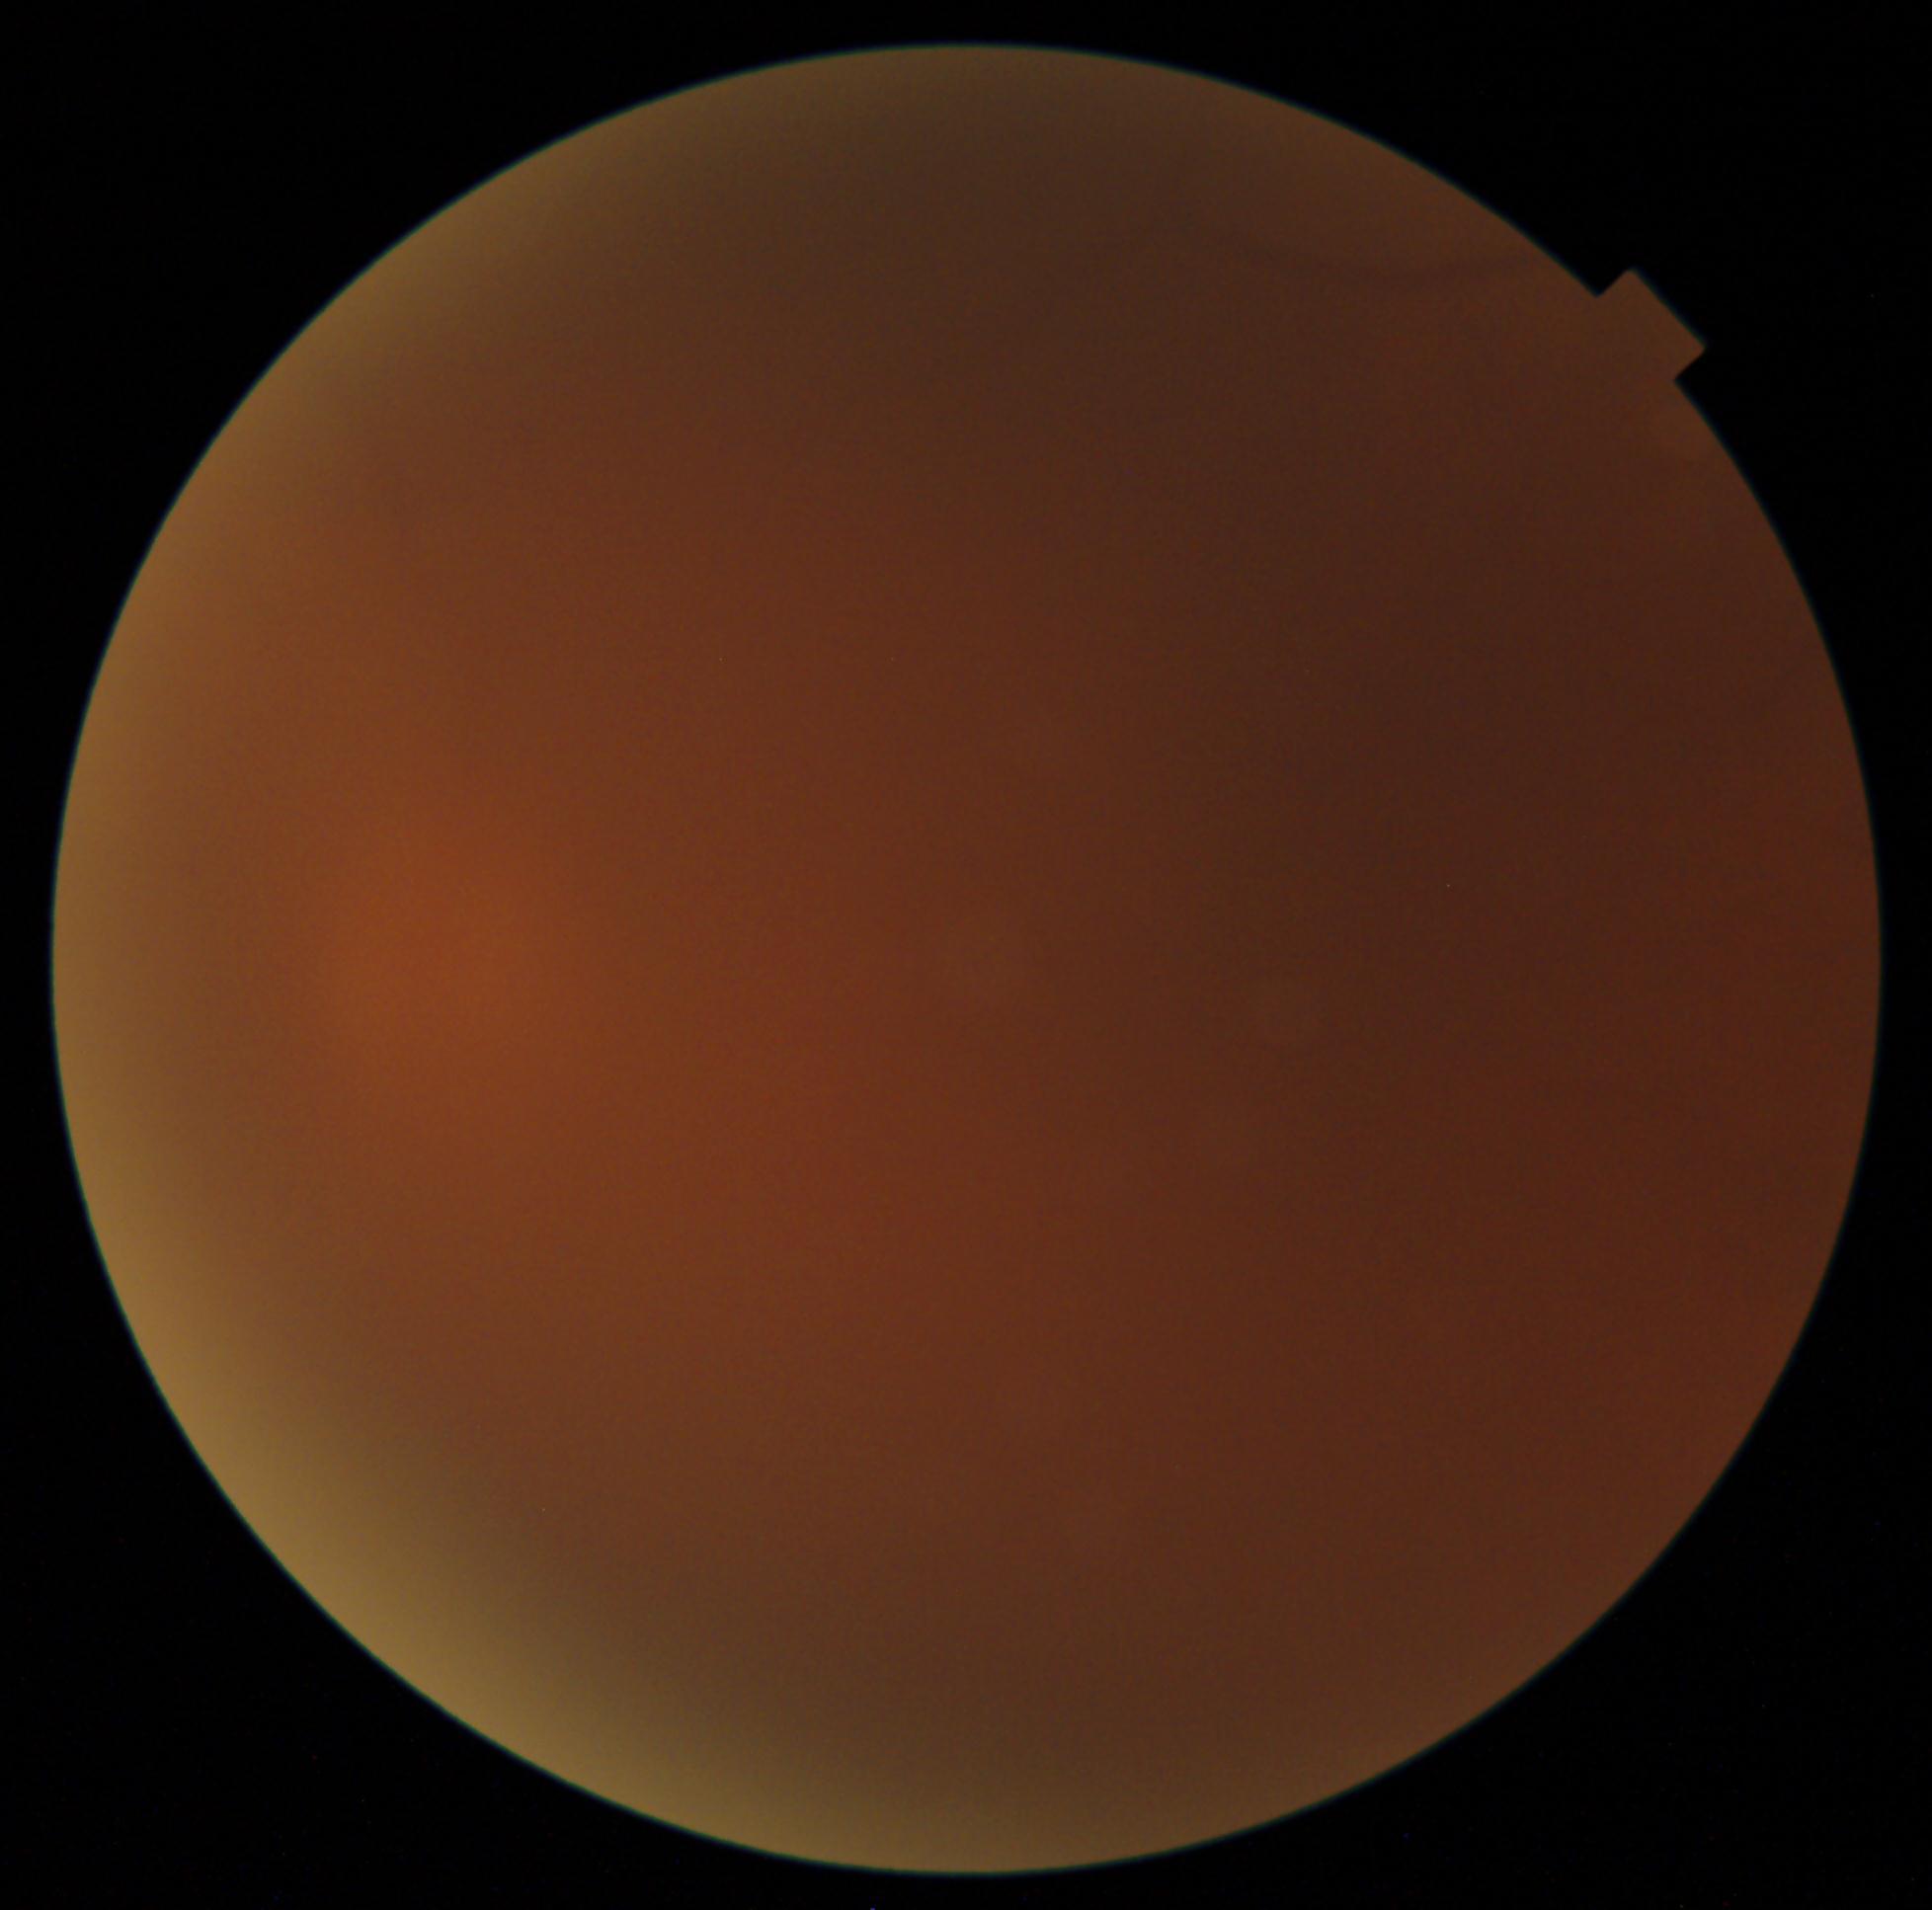 diabetic retinopathy (DR) = ungradable due to poor image quality